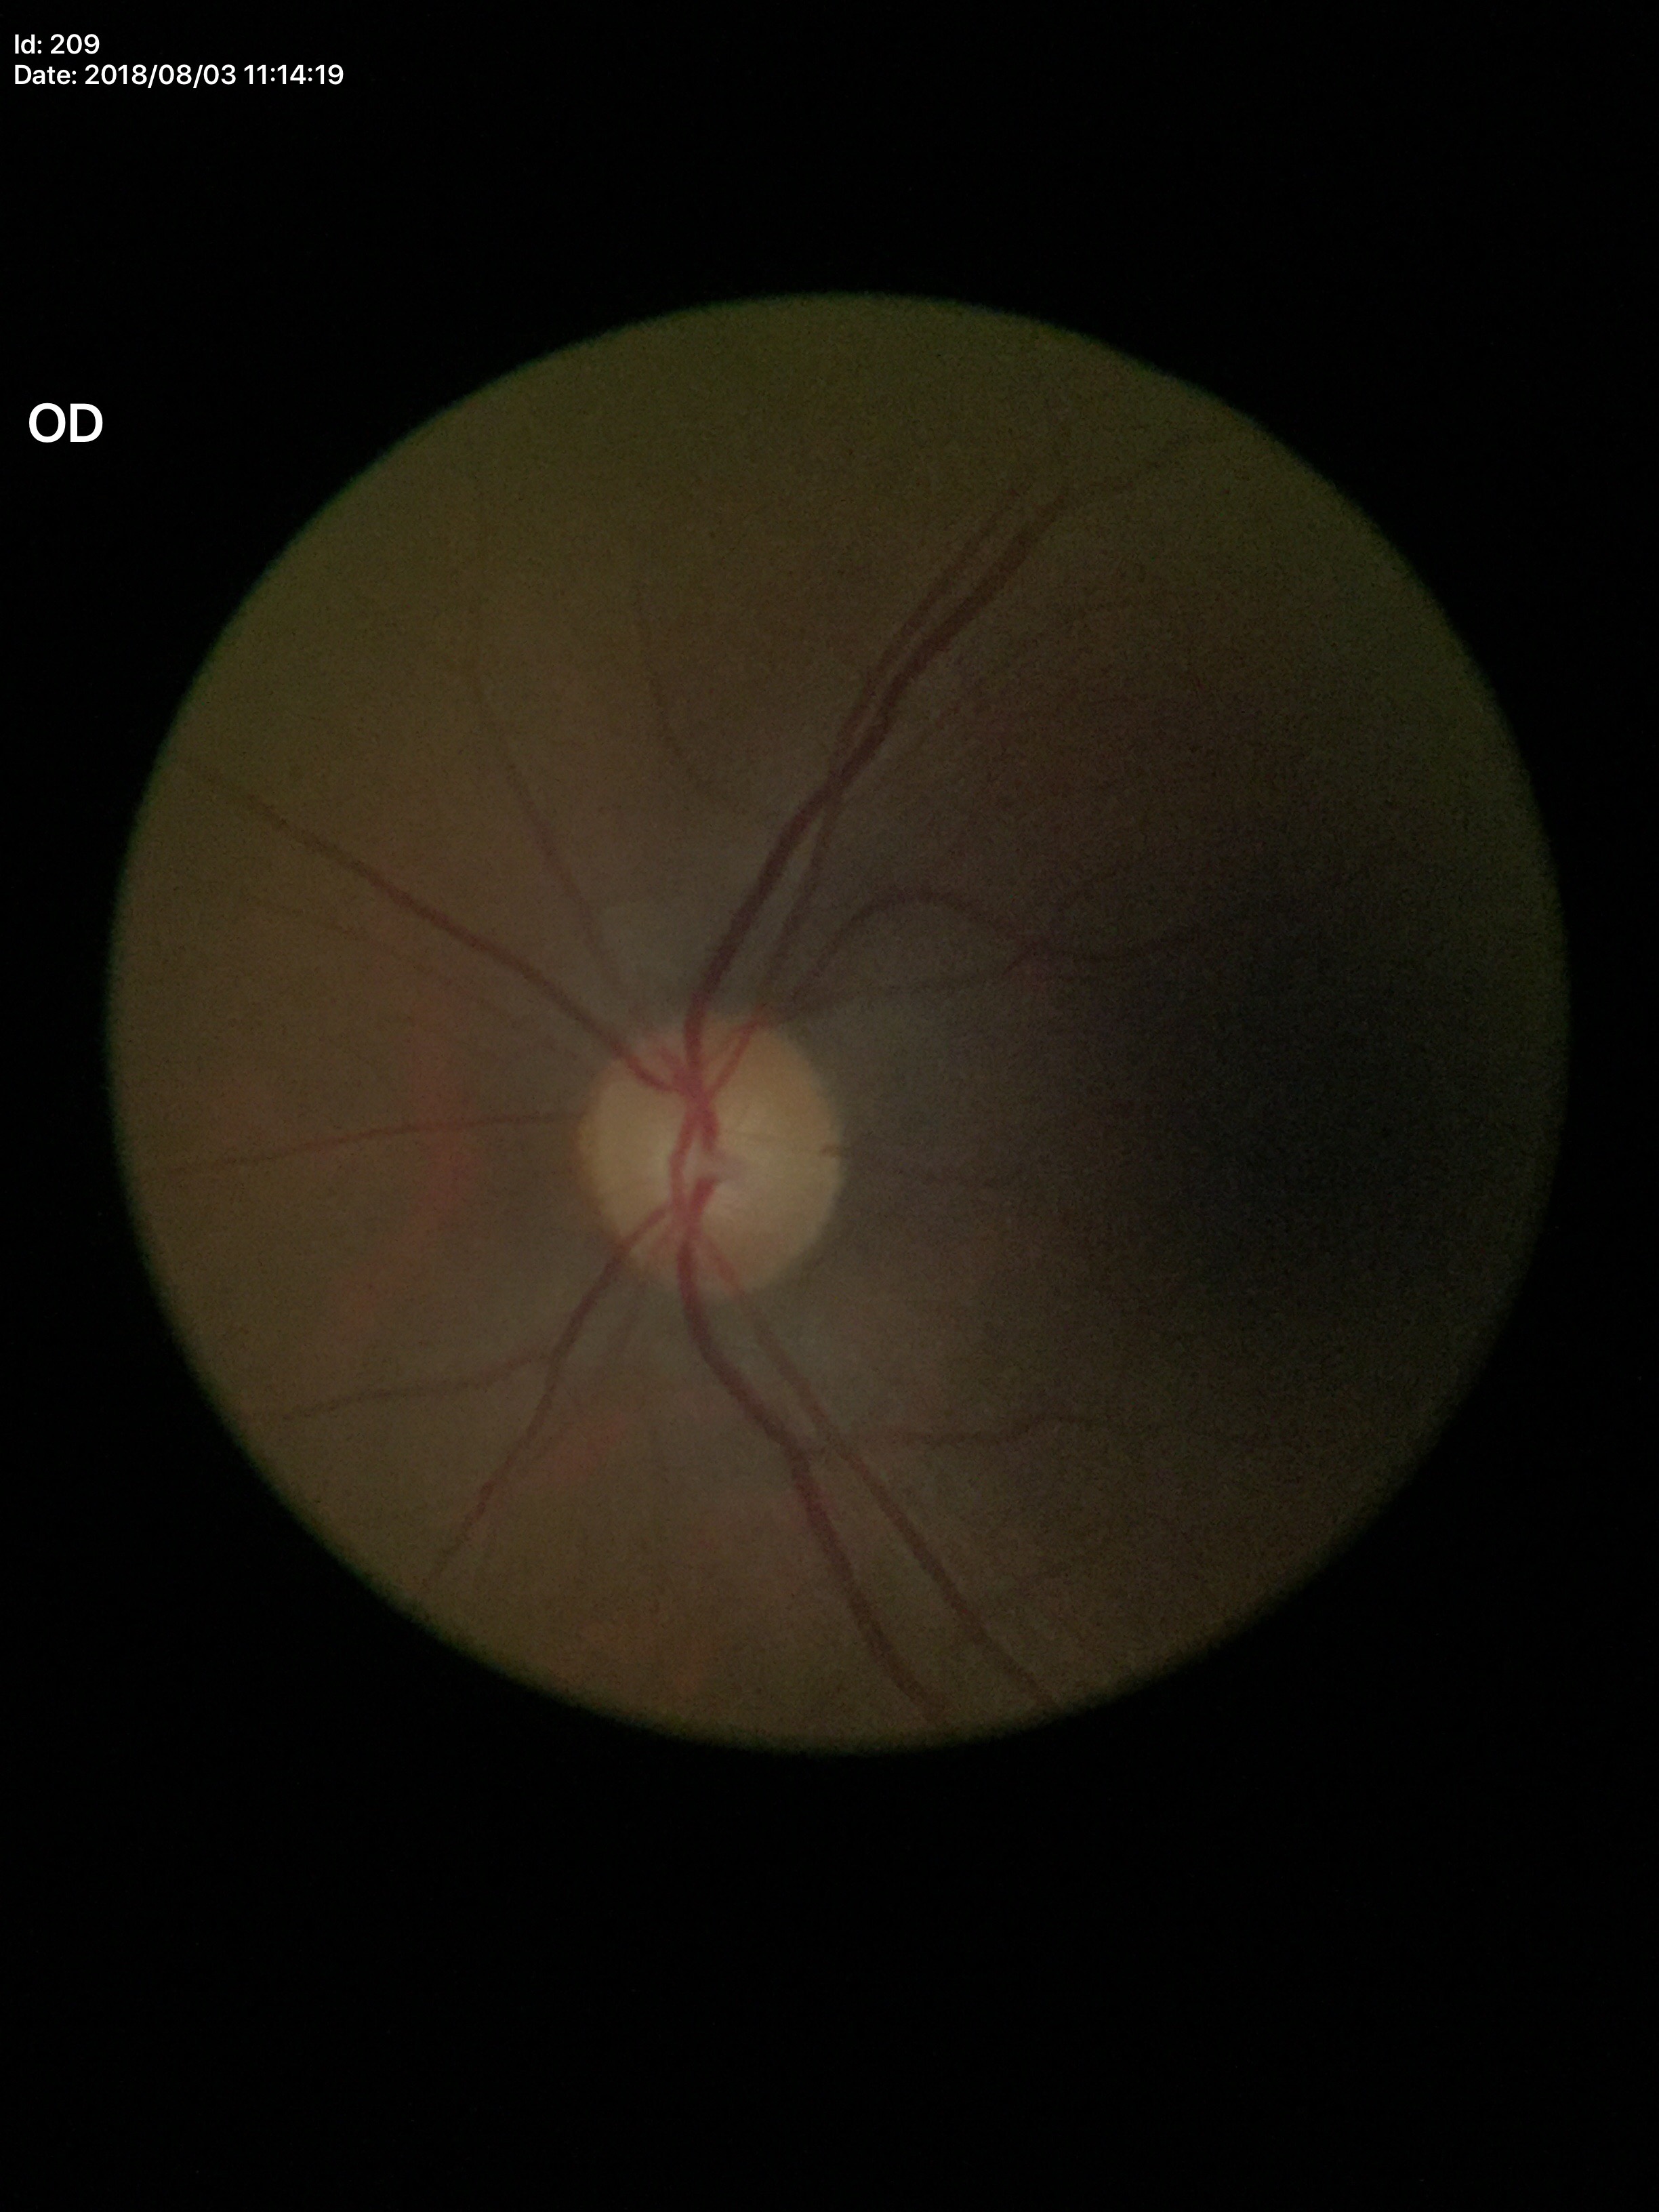
Glaucoma evaluation = negative (5/5 ophthalmologists in agreement) | vertical C/D ratio (VCDR) = 0.46.